Retinal fundus photograph; 2346x1568.
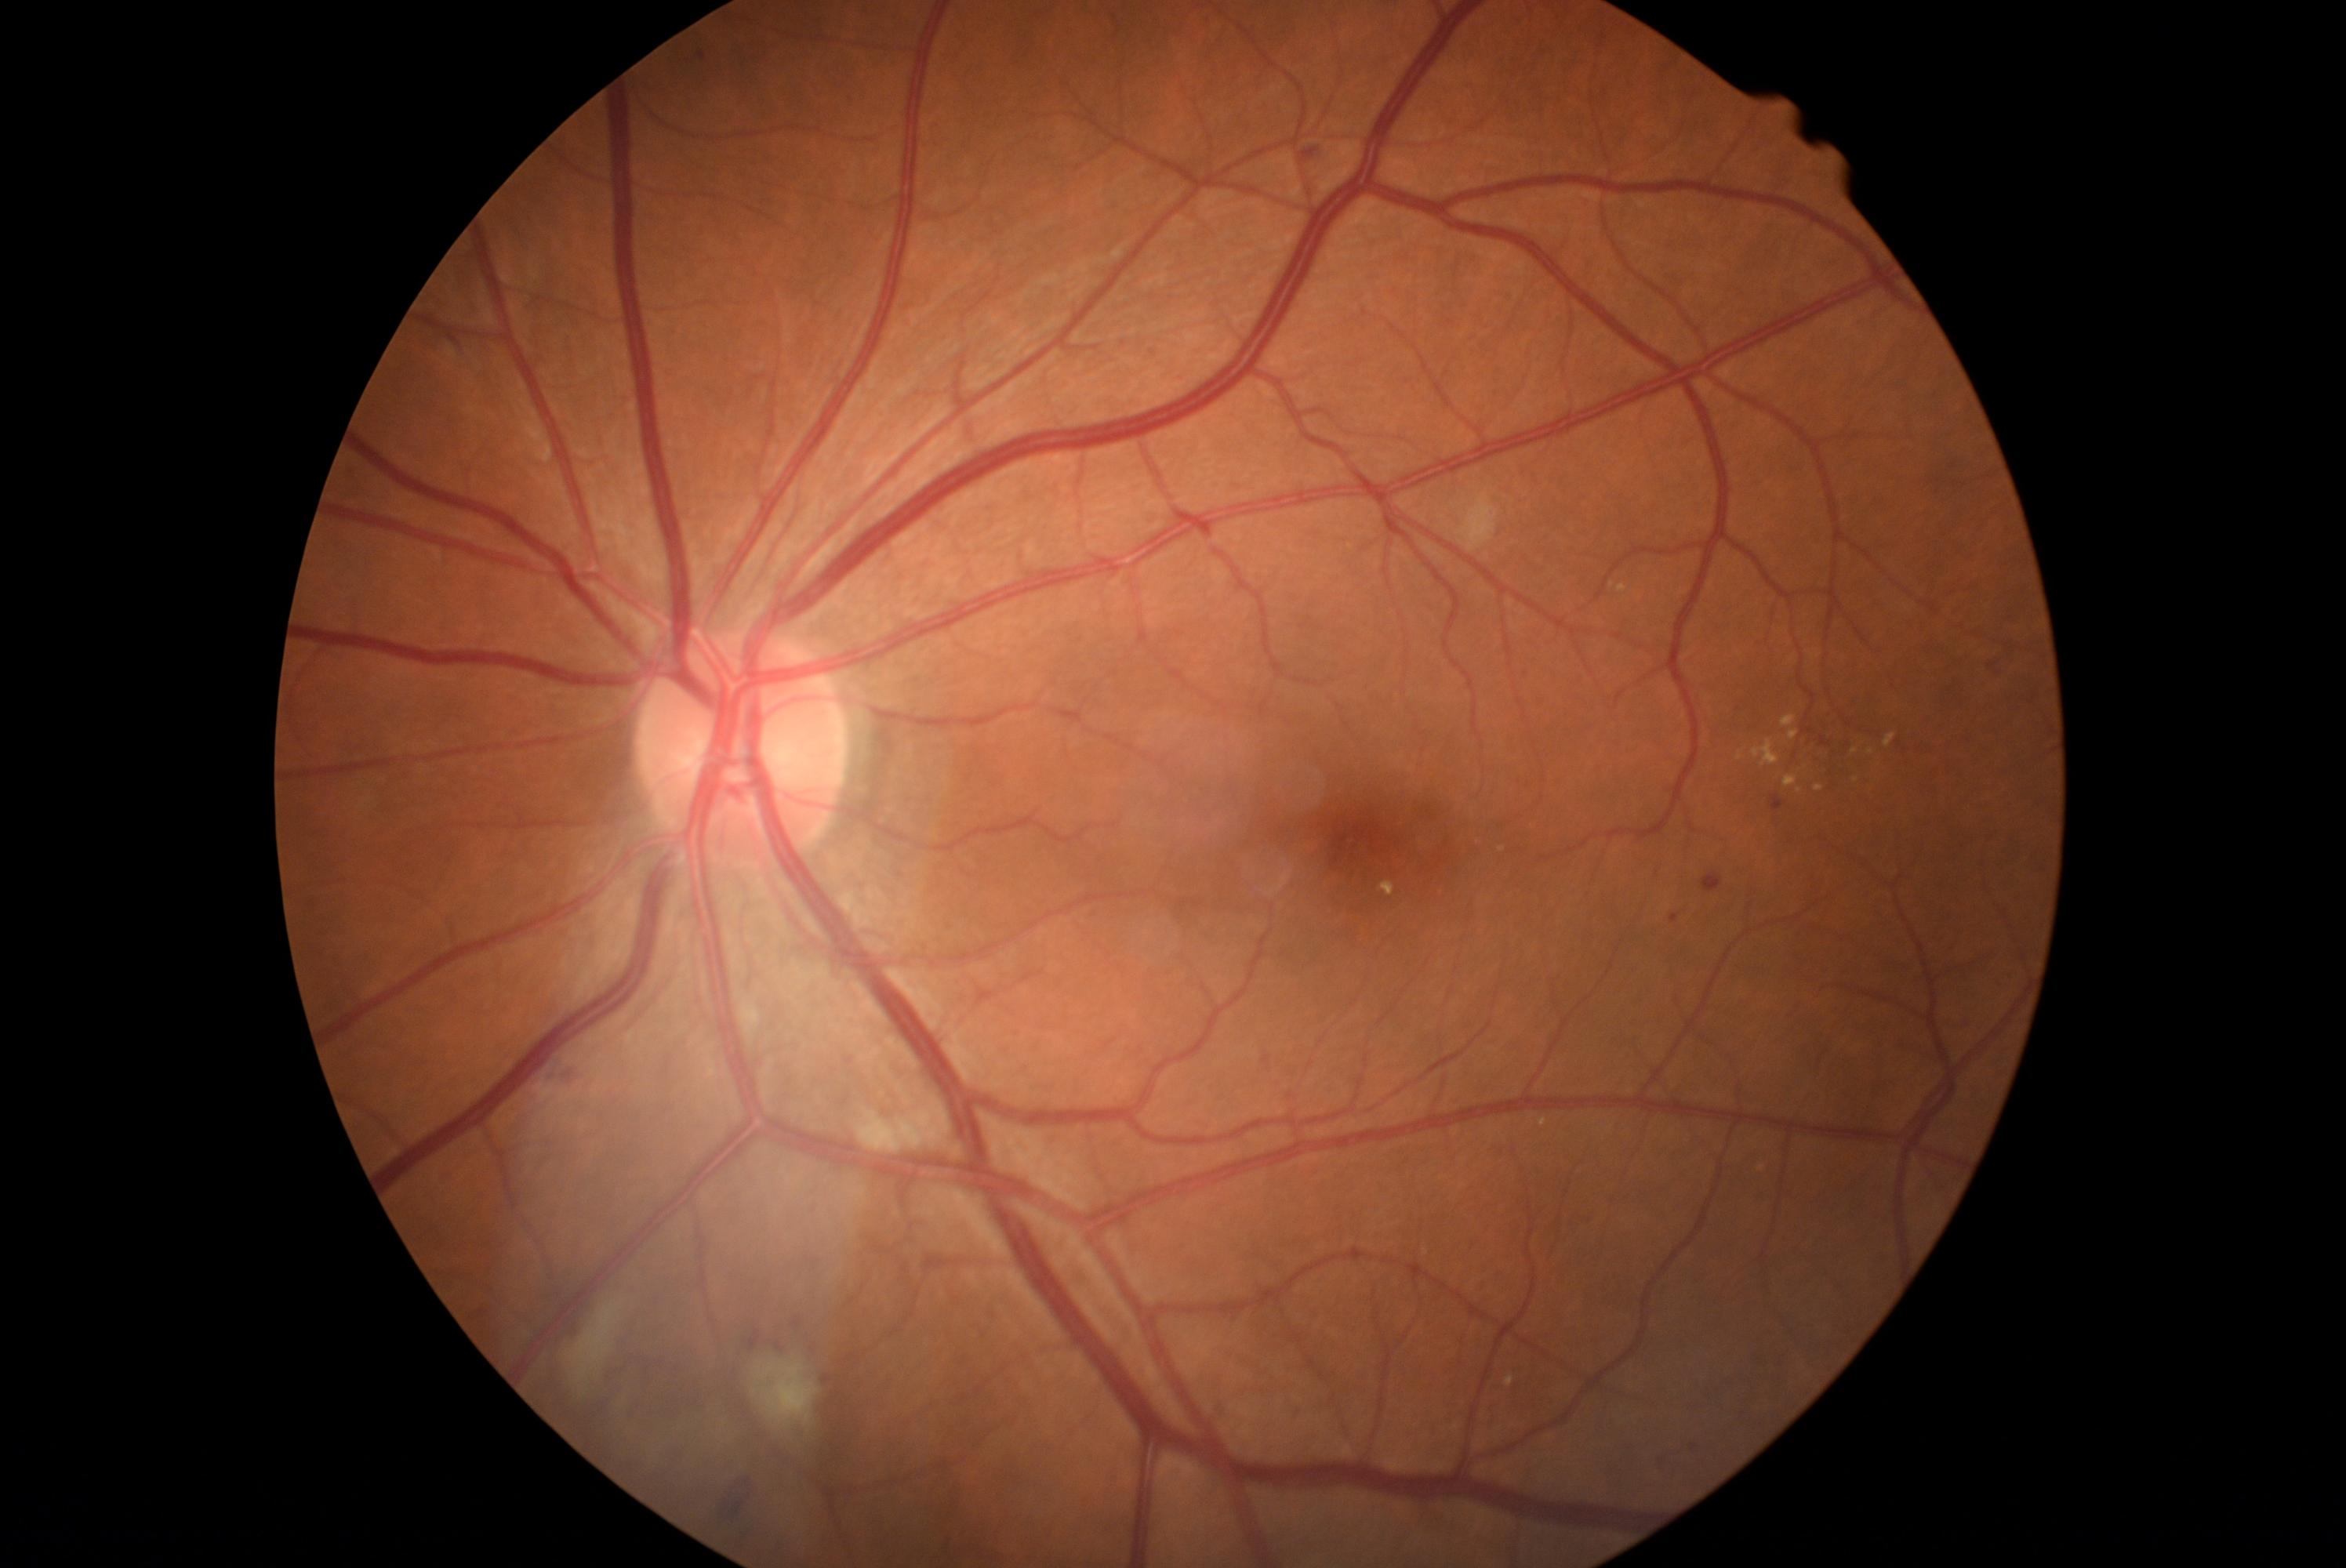 Diabetic retinopathy (DR) is moderate NPDR (grade 2)
Representative lesions:
hemorrhages (HEs) (continued): x1=1301, y1=147, x2=1318, y2=161, x1=724, y1=1487, x2=747, y2=1519, x1=557, y1=1058, x2=581, y2=1084
soft exudates (SEs): x1=857, y1=1109, x2=940, y2=1153, x1=567, y1=1301, x2=626, y2=1390, x1=752, y1=1357, x2=821, y2=1429, x1=1448, y1=490, x2=1500, y2=553
microaneurysms (MAs): x1=697, y1=51, x2=708, y2=60, x1=793, y1=1319, x2=802, y2=1327, x1=1671, y1=915, x2=1679, y2=923, x1=1691, y1=1443, x2=1698, y2=1451, x1=1702, y1=873, x2=1723, y2=891, x1=1770, y1=796, x2=1784, y2=811, x1=775, y1=1341, x2=786, y2=1351, x1=1801, y1=727, x2=1815, y2=735, x1=1649, y1=1456, x2=1663, y2=1461, x1=752, y1=1330, x2=760, y2=1351, x1=1821, y1=736, x2=1831, y2=747
MAs (small, approximate centers) near (827,1380), (1991,665)
hard exudates (EXs): x1=1738, y1=750, x2=1745, y2=760, x1=1814, y1=785, x2=1825, y2=793, x1=1789, y1=730, x2=1799, y2=739, x1=1751, y1=739, x2=1781, y2=768, x1=1784, y1=777, x2=1798, y2=788, x1=1782, y1=714, x2=1796, y2=727, x1=1884, y1=735, x2=1897, y2=749, x1=1618, y1=584, x2=1629, y2=592
EXs (small, approximate centers) near (1871,752), (1856,781), (1856,751), (1798,791)